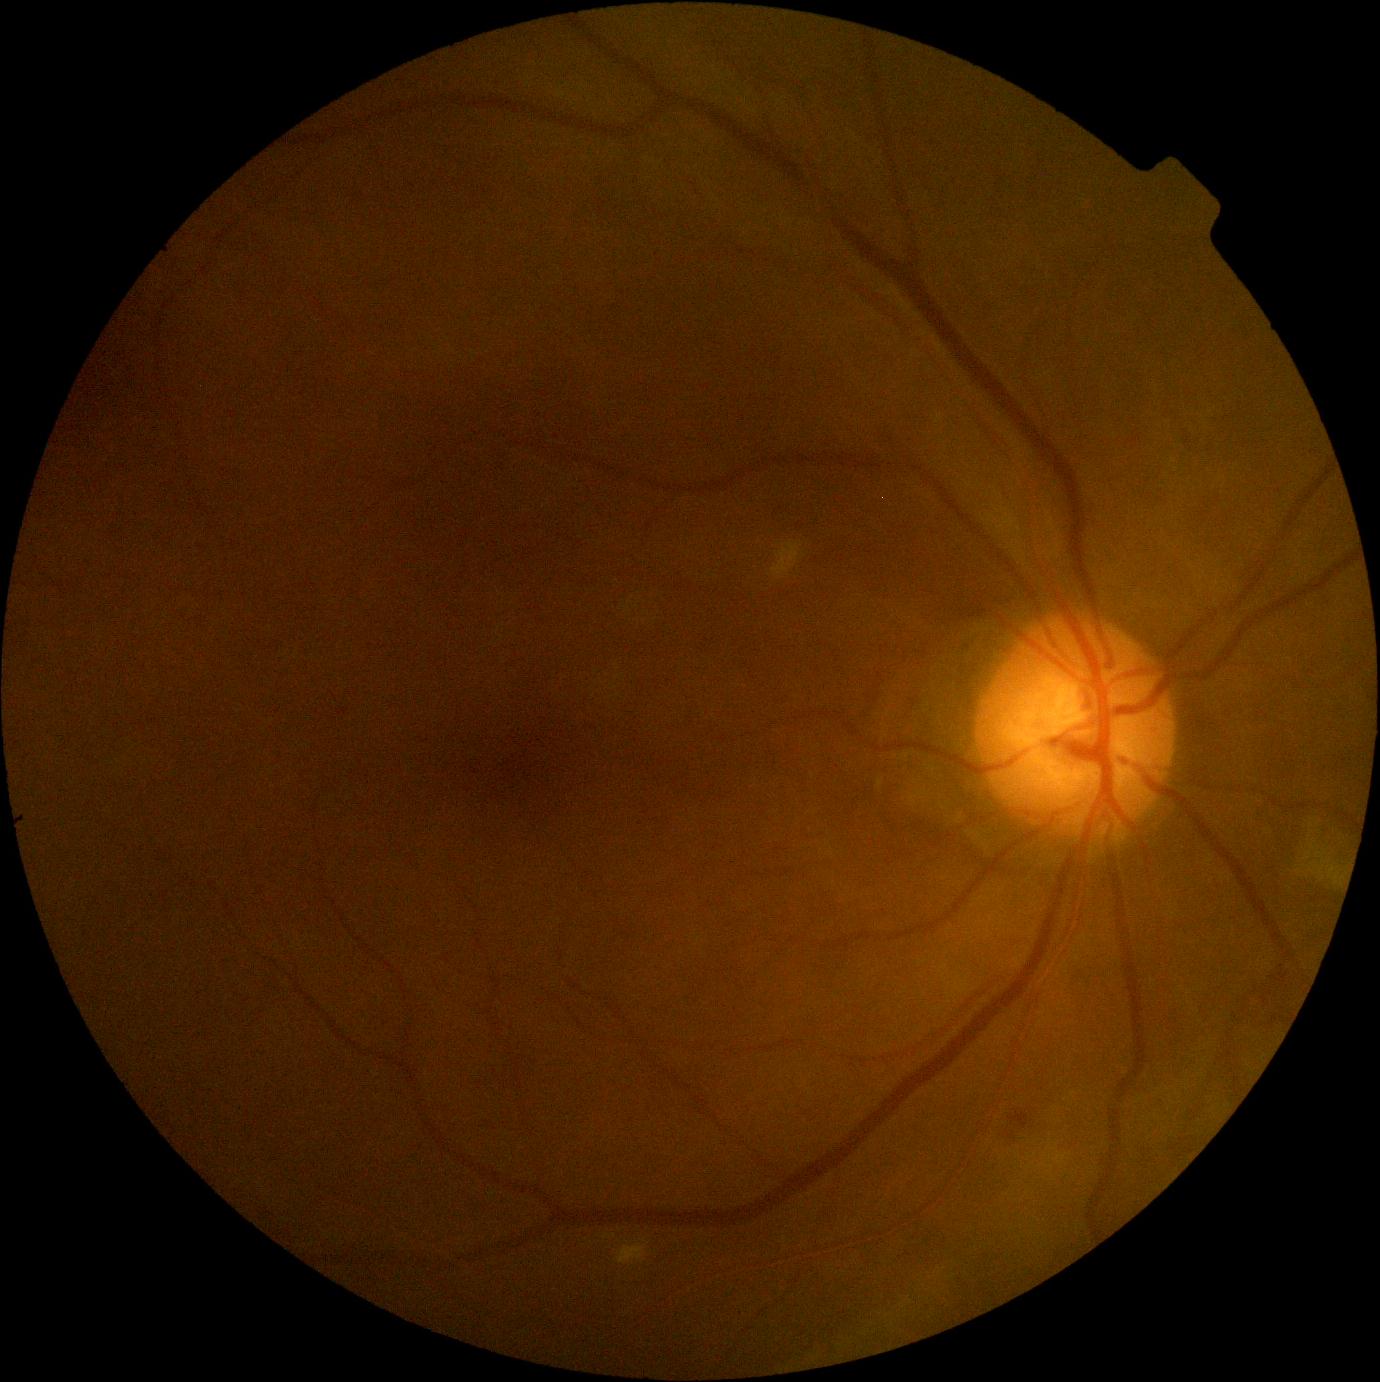

DR grade is 2/4 — more than just microaneurysms but less than severe NPDR.